45-degree field of view; retinal fundus photograph.
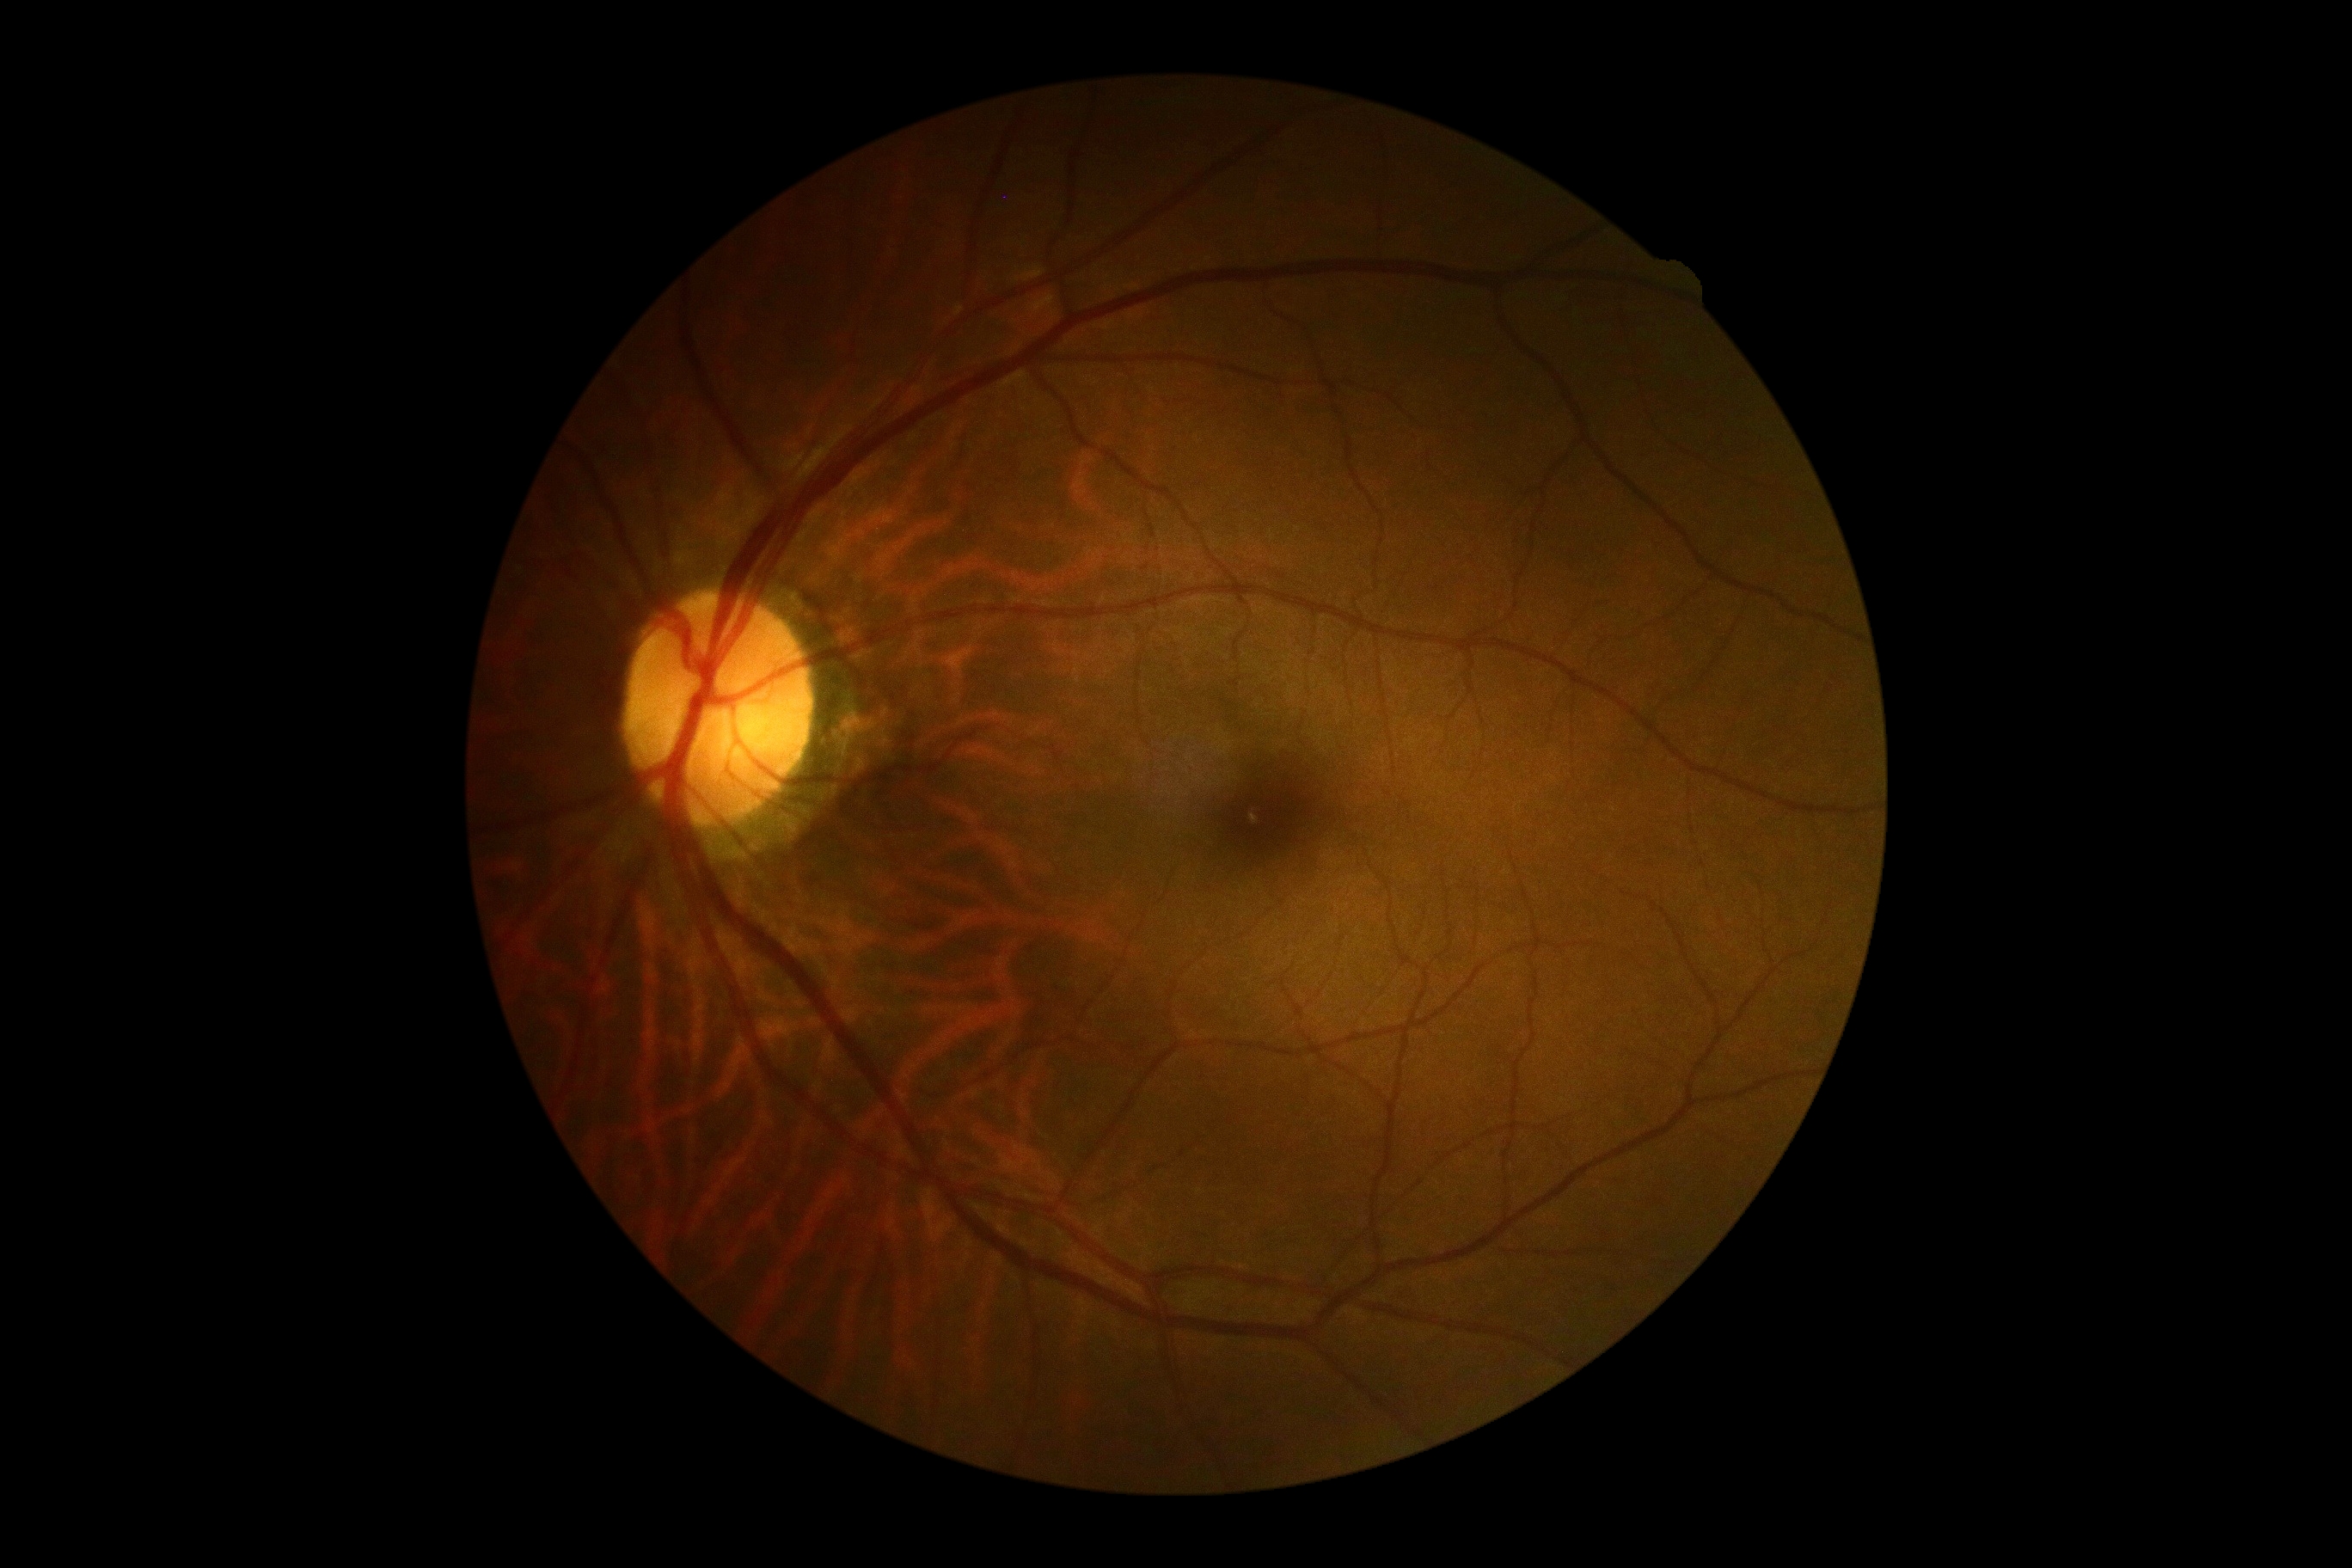
• diabetic retinopathy grade — 0 (no apparent retinopathy)
• DR impression — no apparent DR